2352x1568px. 45° FOV. Color fundus photograph:
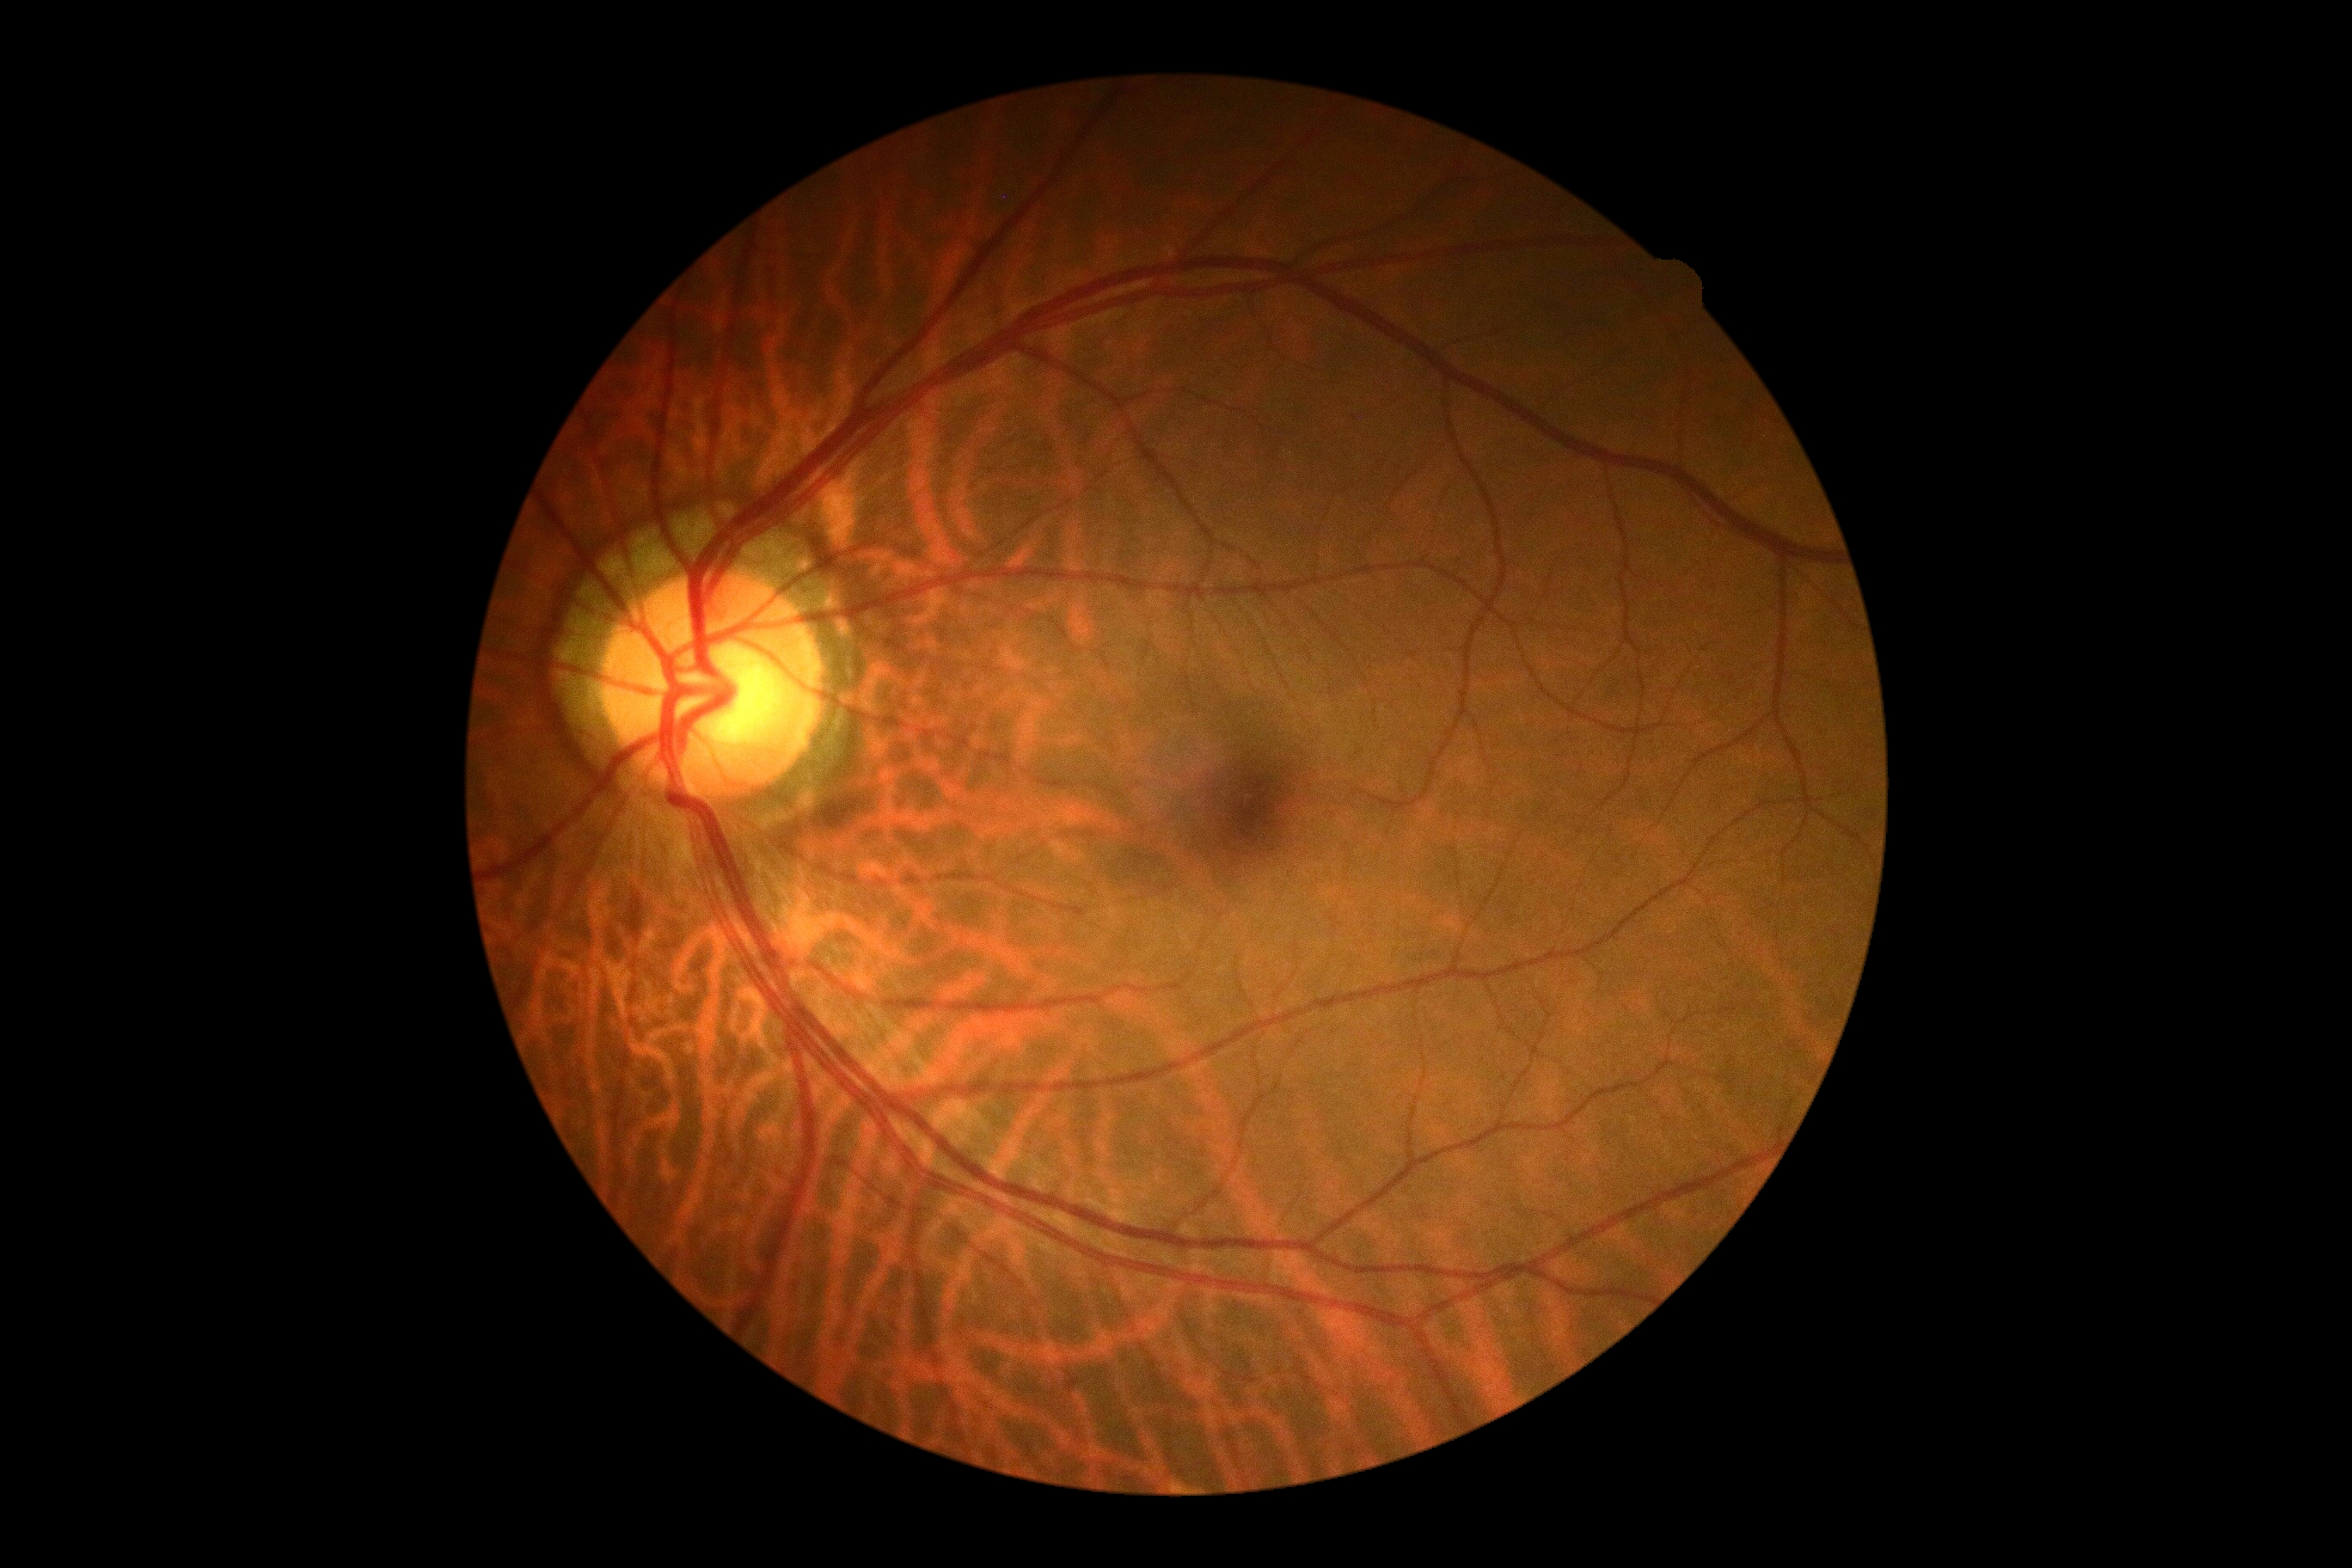

No signs of diabetic retinopathy. DR stage is grade 0 (no apparent retinopathy).